RetCam wide-field infant fundus image. 640 x 480 pixels. Camera: Clarity RetCam 3 (130° FOV): 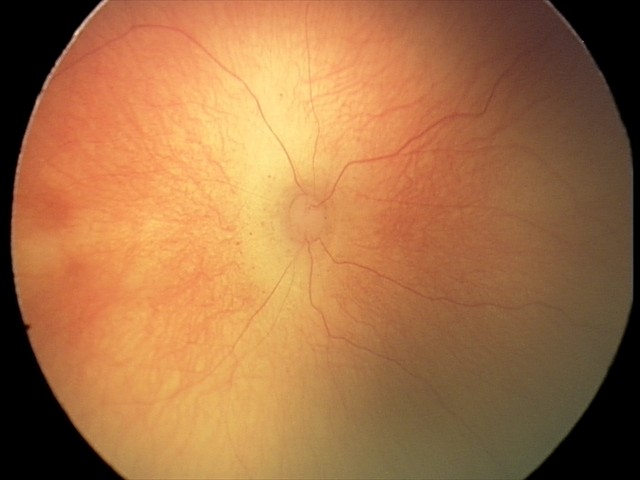 No plus disease. Series diagnosed as retinopathy of prematurity (ROP) stage 1.